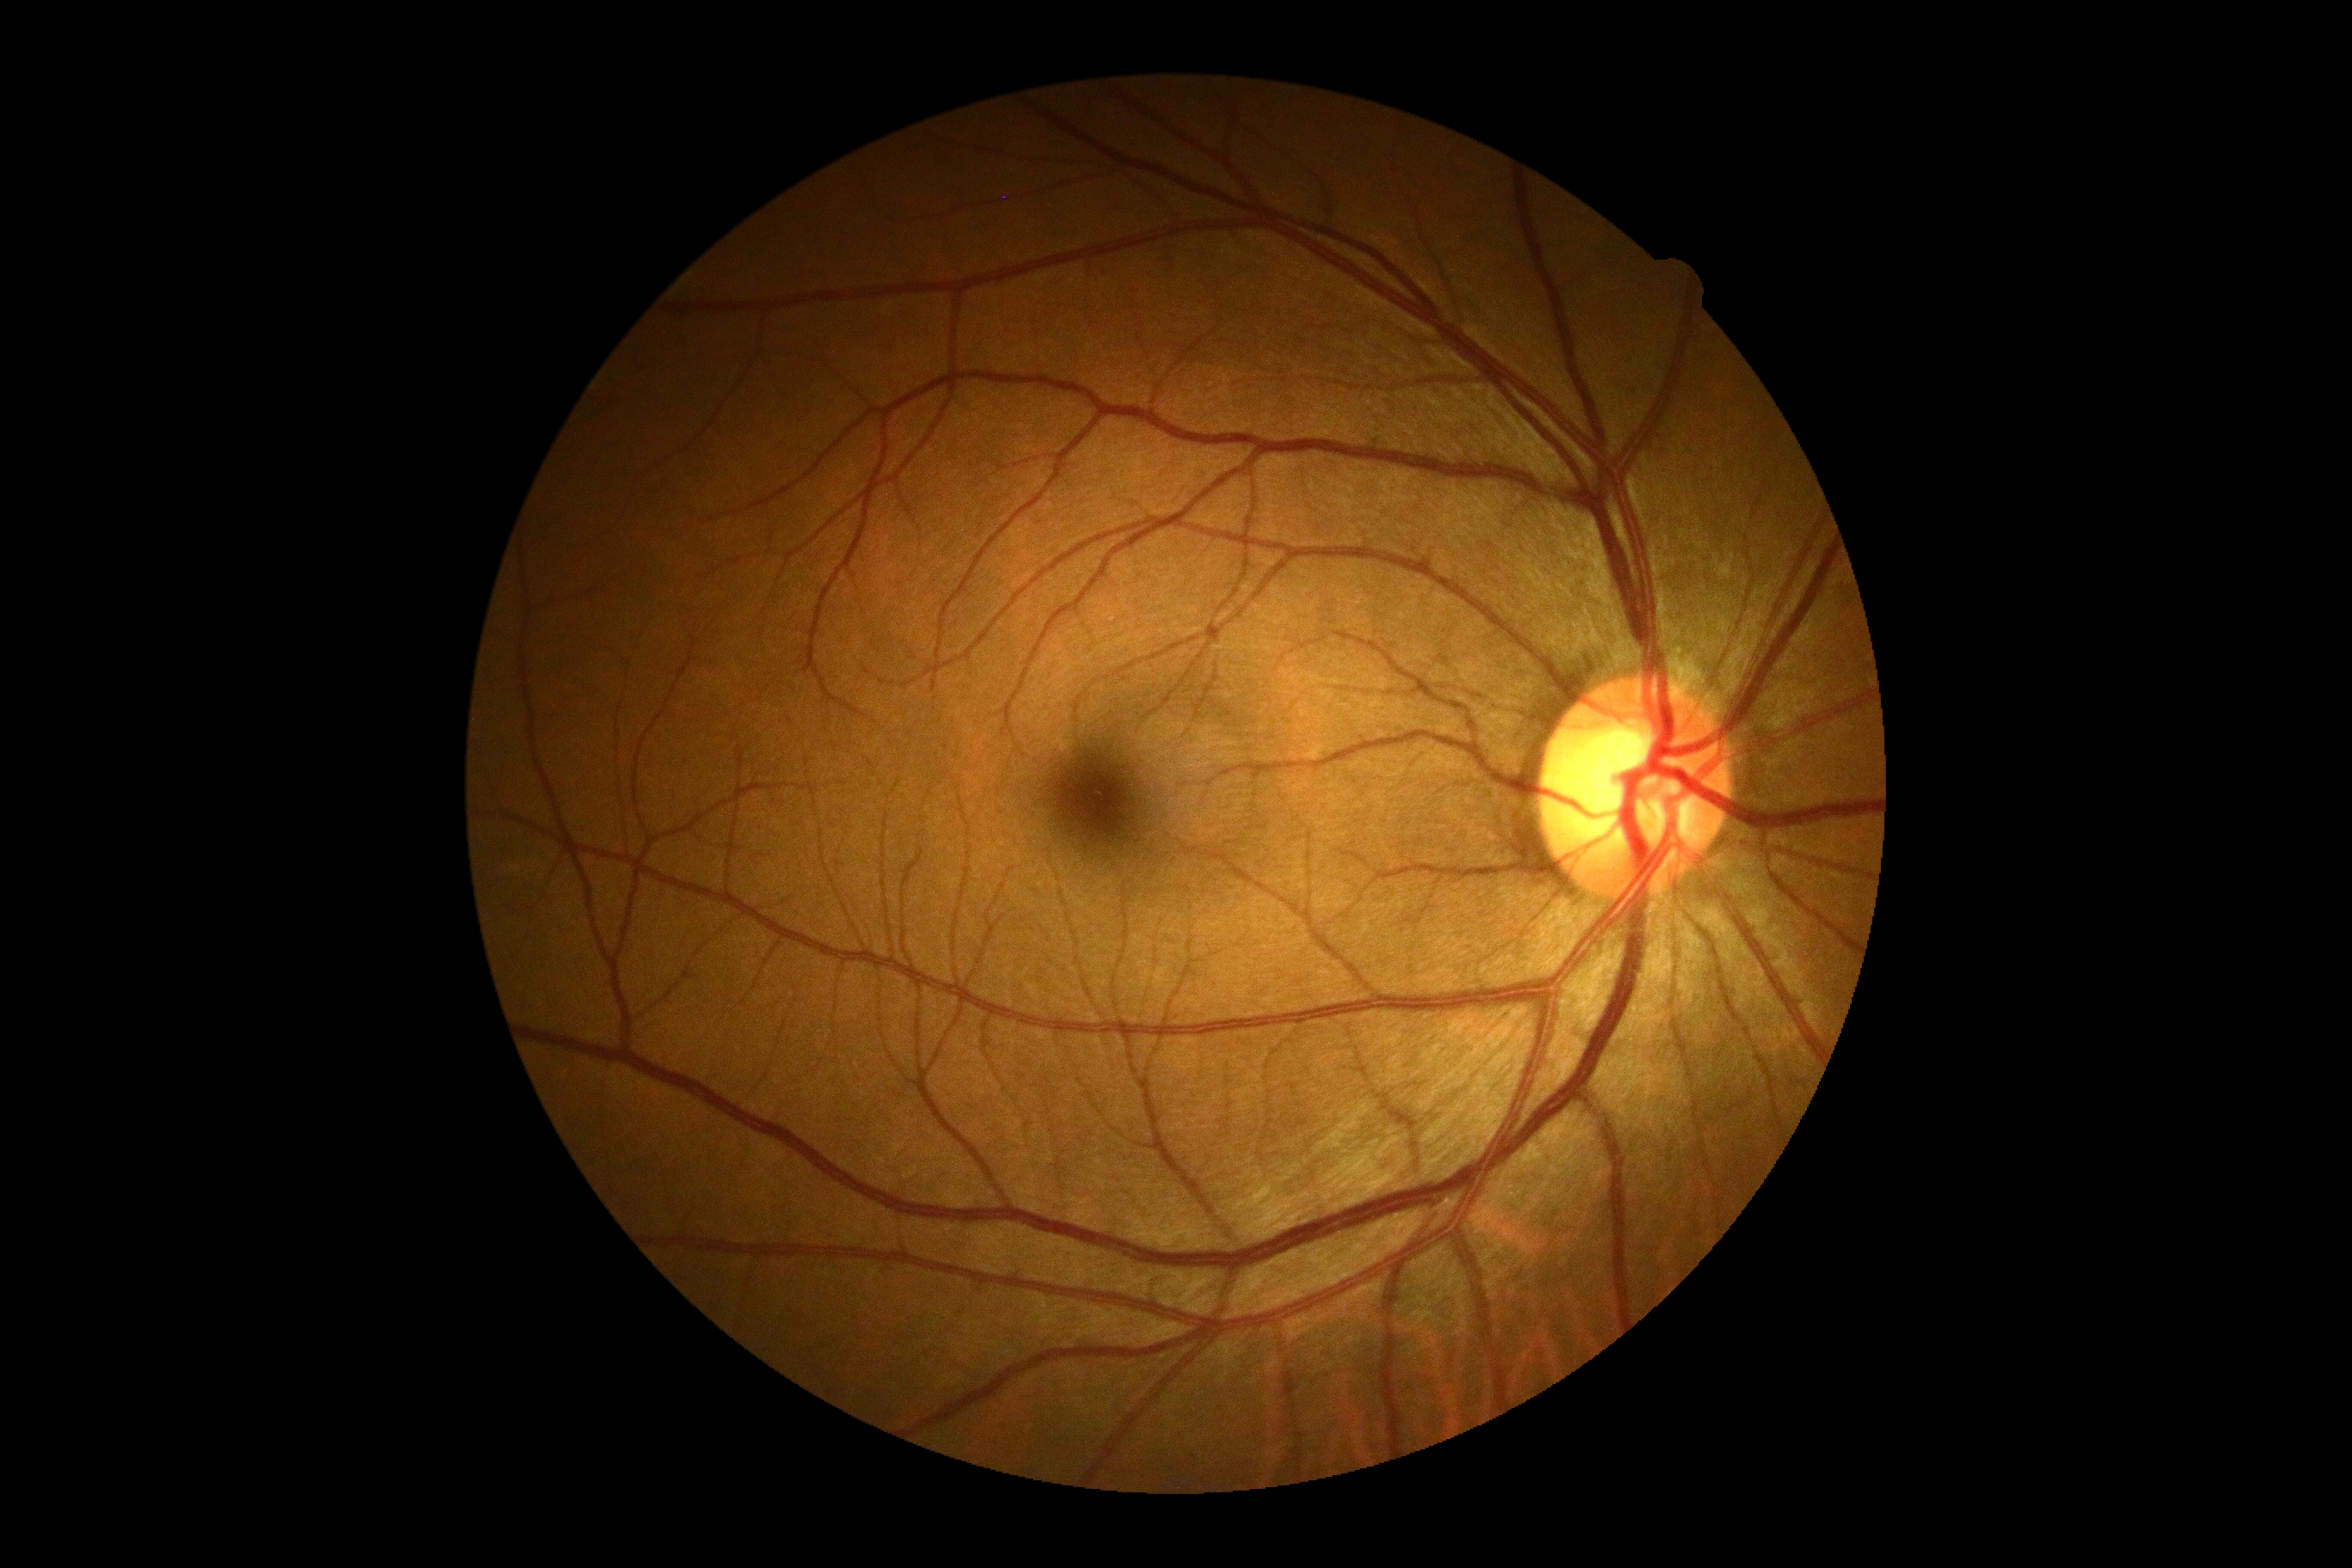

Annotations:
* DR severity: grade 0 (no apparent retinopathy)